2352x1568:
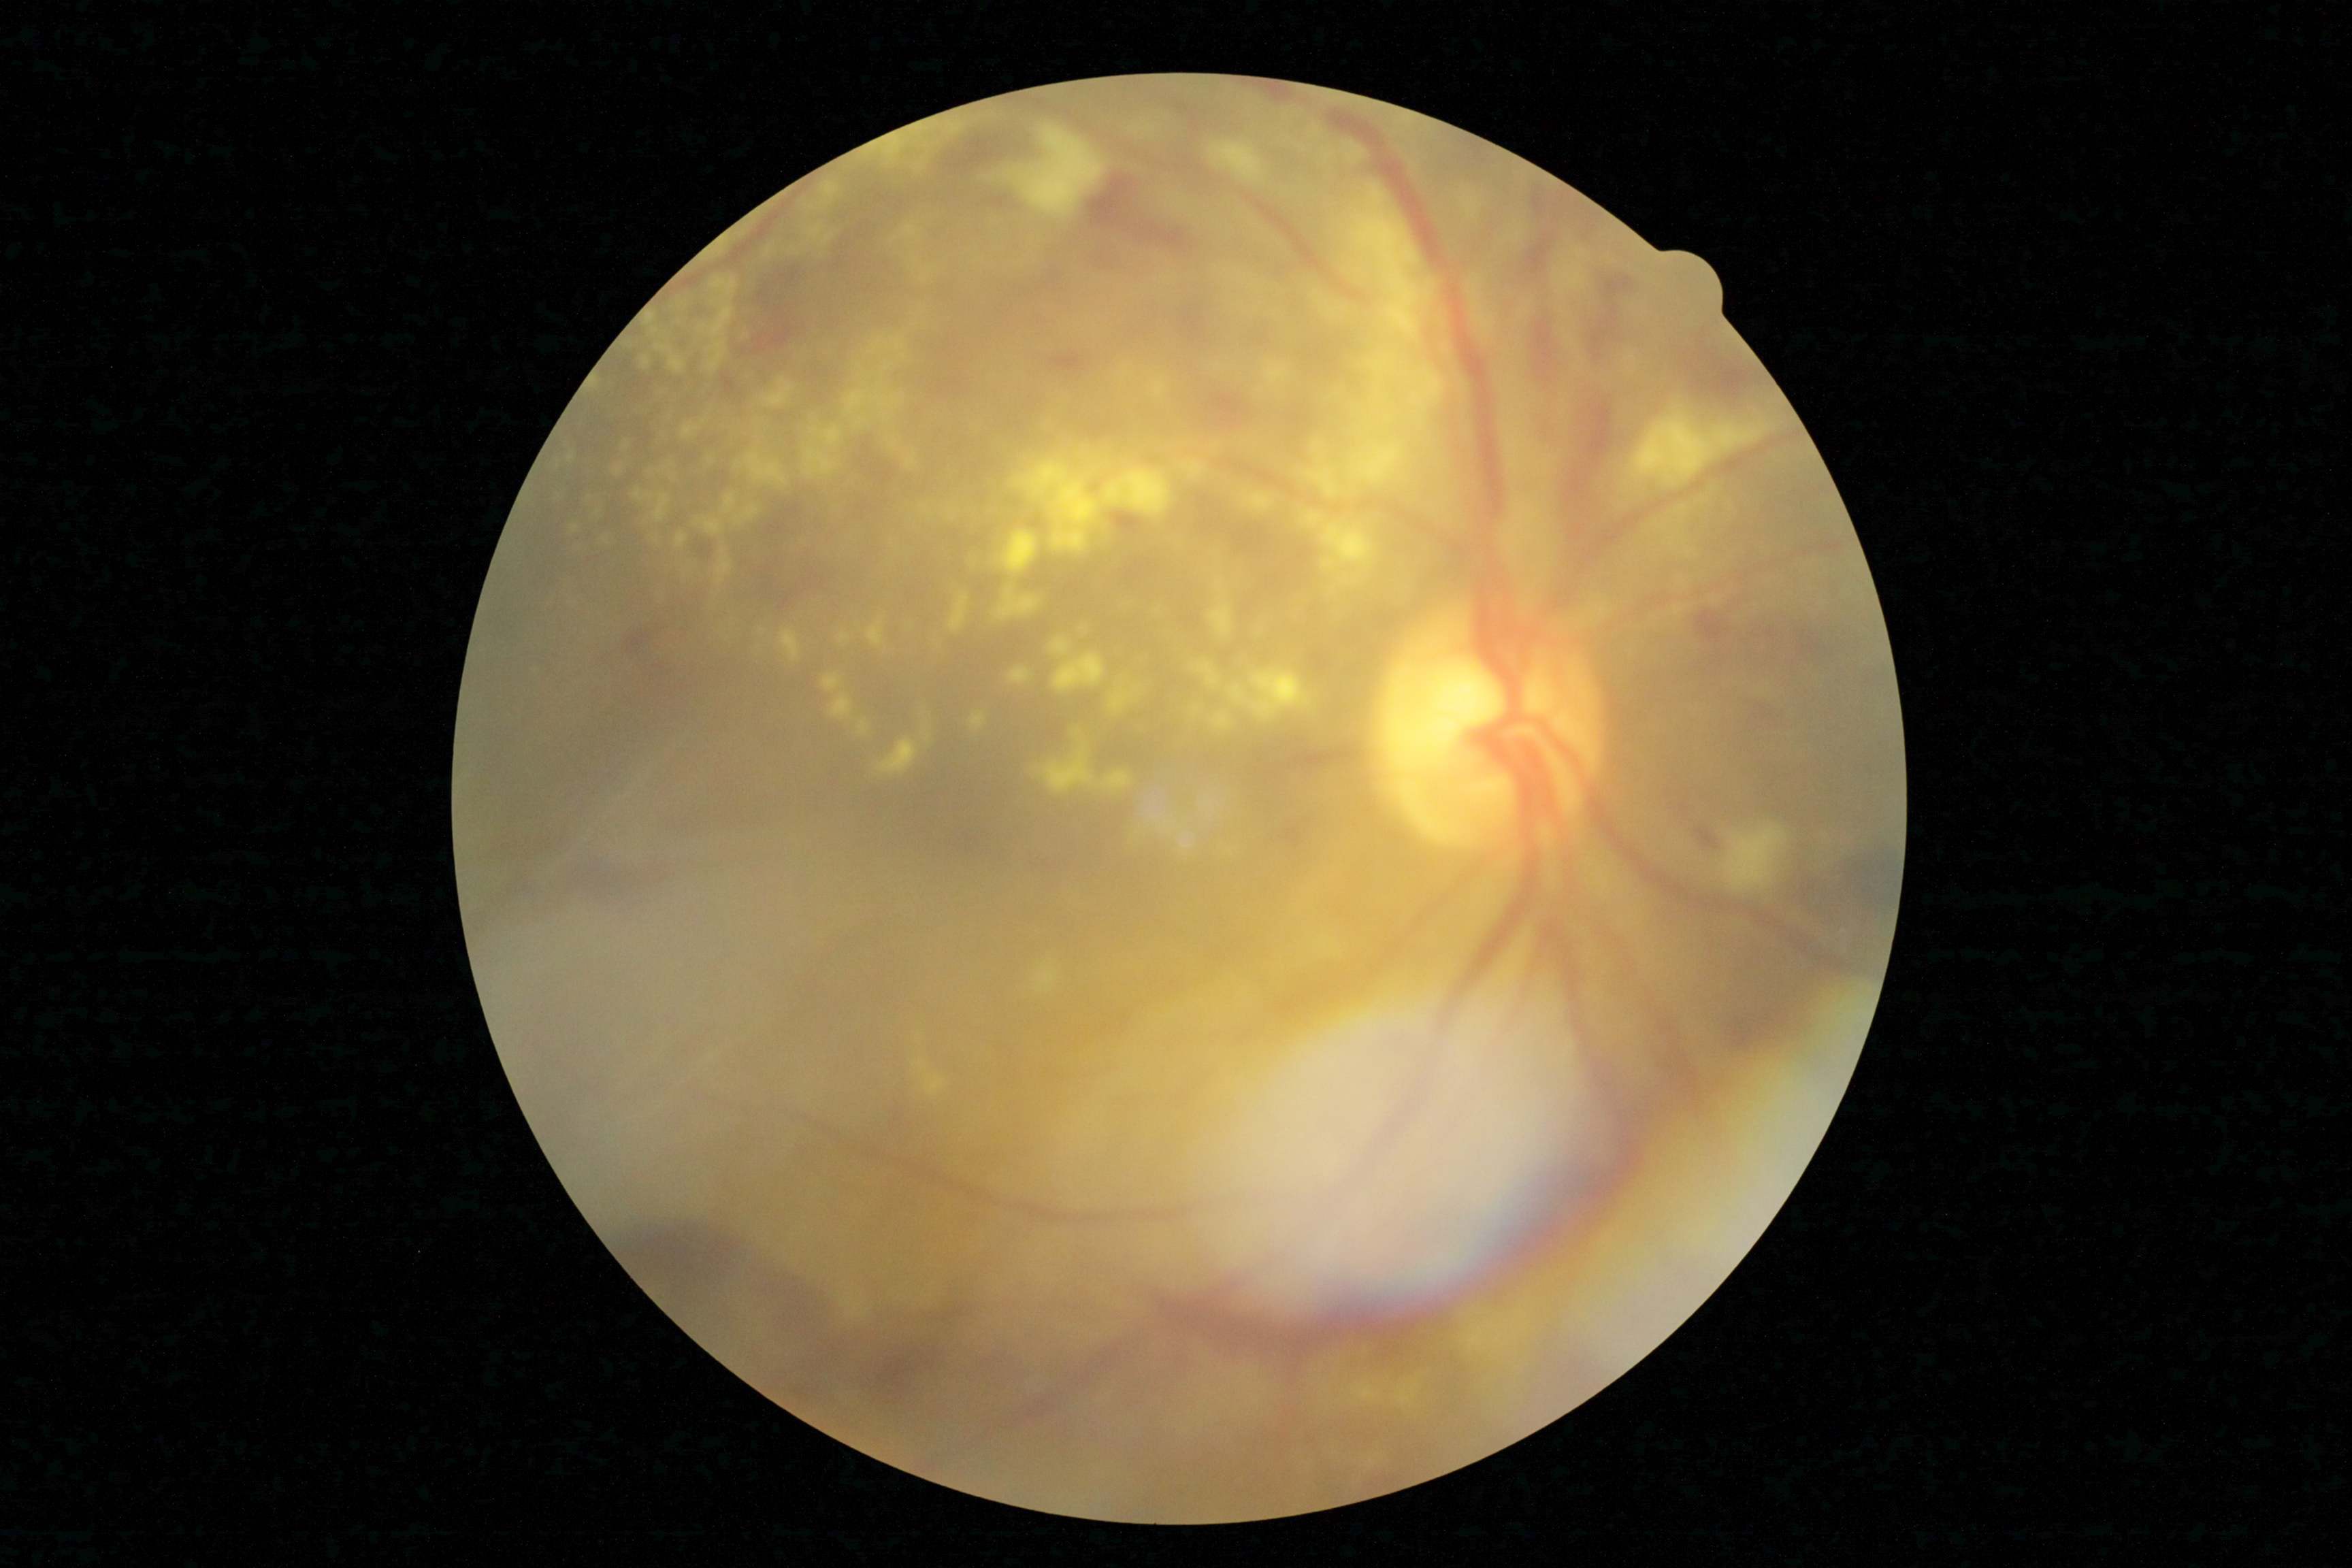 DR class@proliferative diabetic retinopathy; diabetic retinopathy (DR)@4/4.